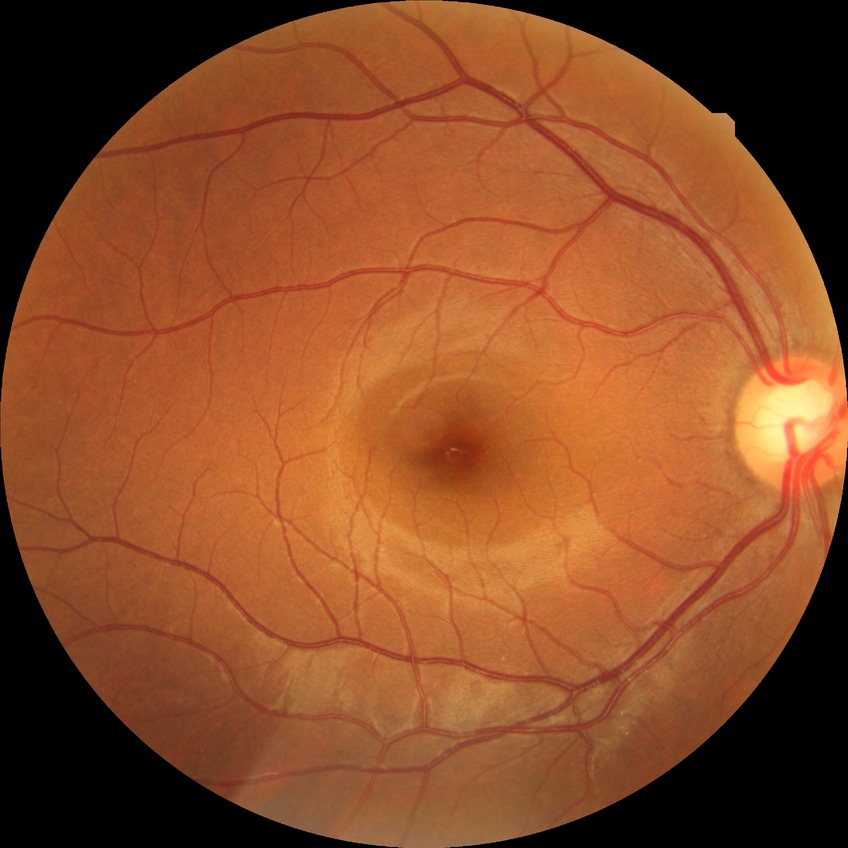 diabetic retinopathy (DR): no diabetic retinopathy (NDR).